45° FOV · NIDEK AFC-230 · nonmydriatic fundus photograph · 848x848px · color fundus image: 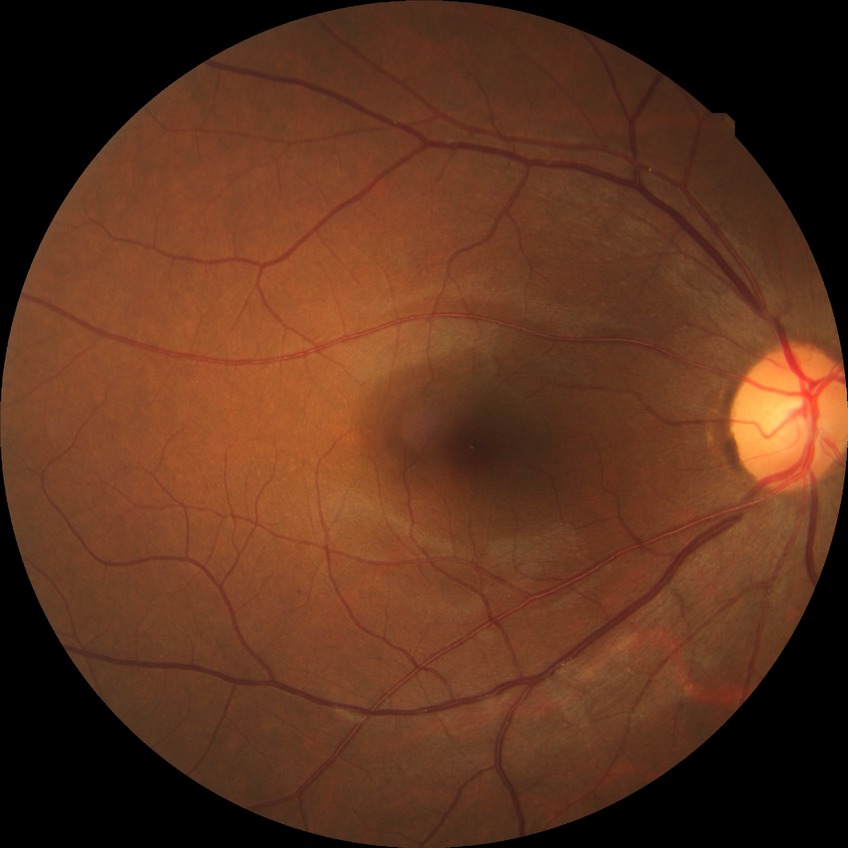

No DR findings.
Modified Davis grade: NDR.